45-degree field of view: 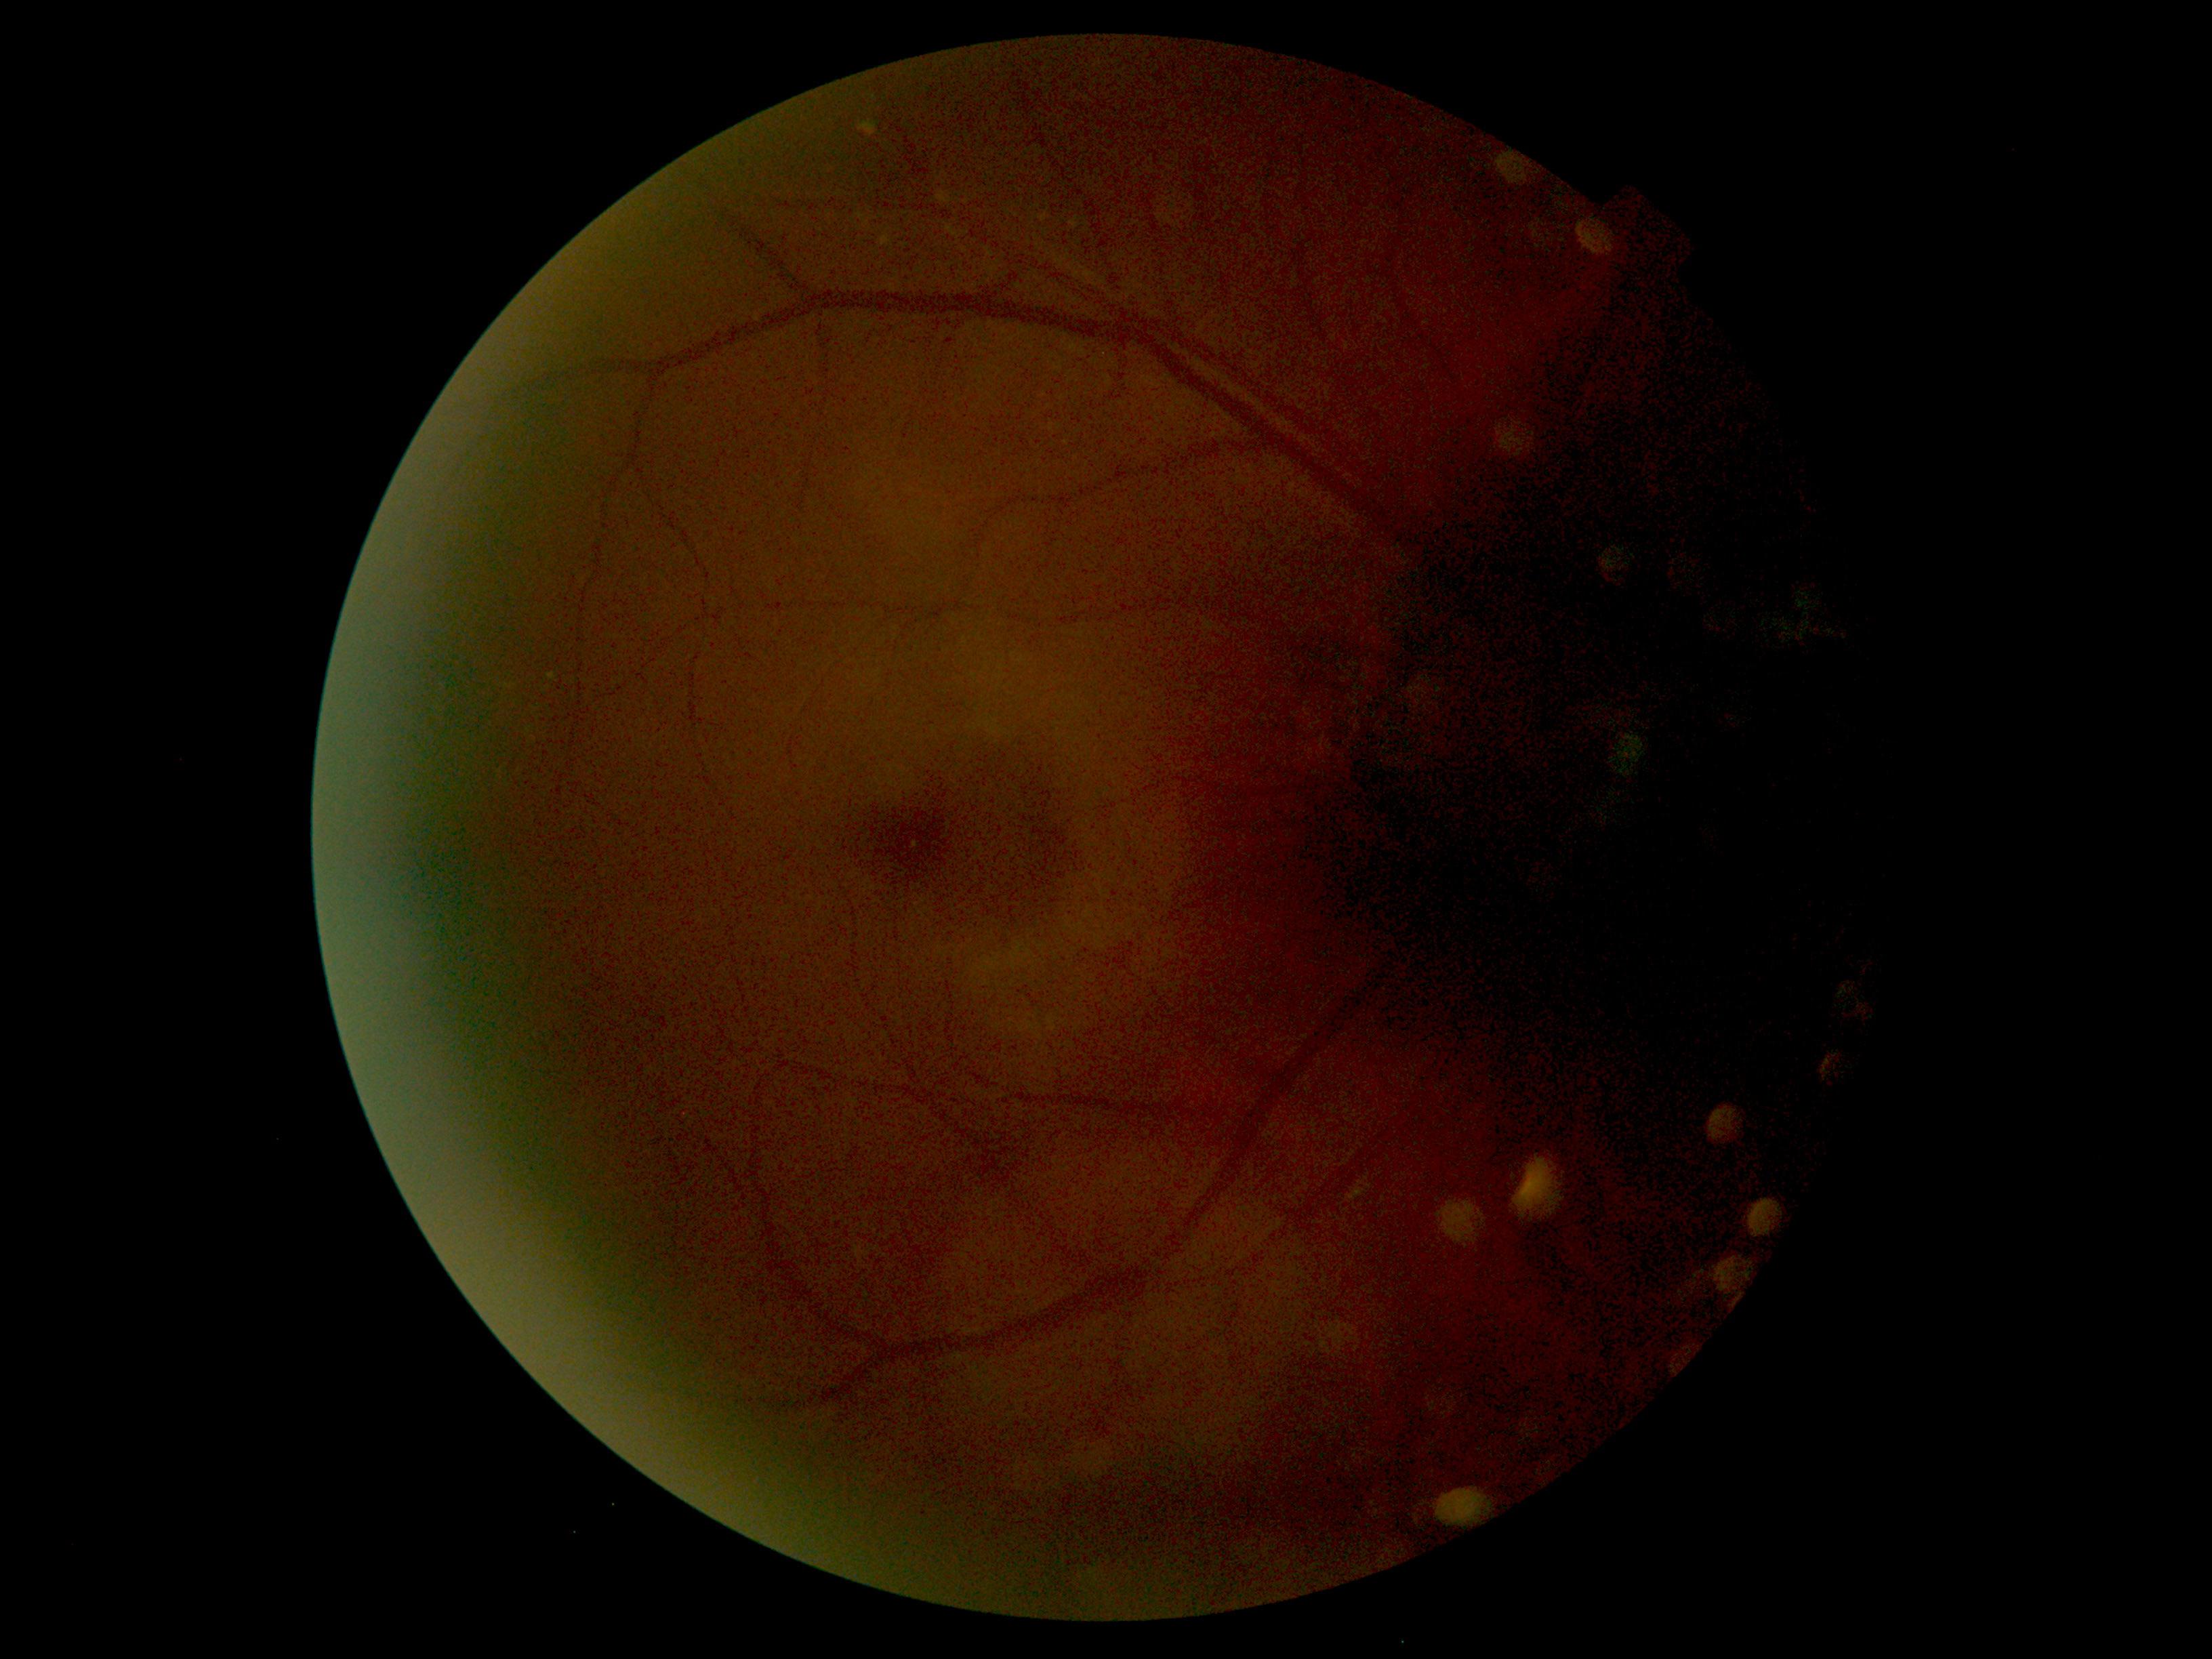

Annotations:
– diabetic retinopathy grade — 0